Nonmydriatic fundus photograph · 45° FOV — 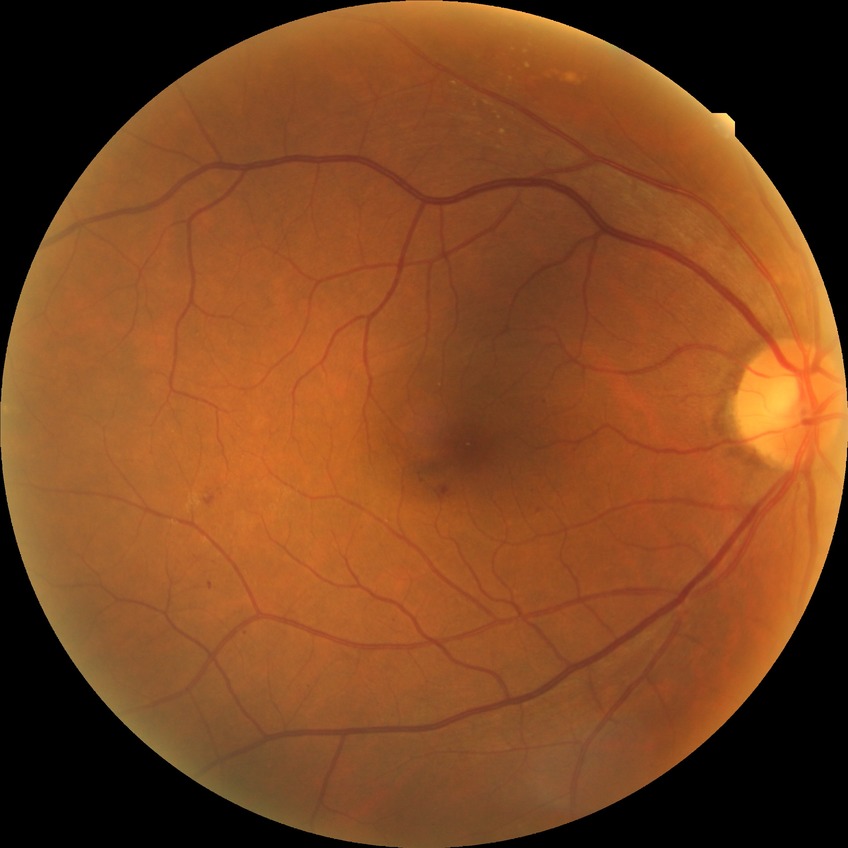
{"proliferative_class": "non-proliferative diabetic retinopathy", "davis_grade": "simple diabetic retinopathy"}